Pediatric retinal photograph (wide-field). Image size 640x480: 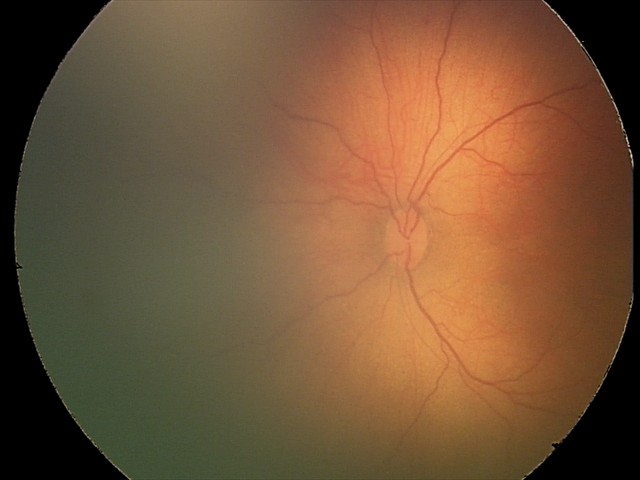

Impression: physiological appearance.